Disc-centered fundus crop; 556 x 515 pixels: 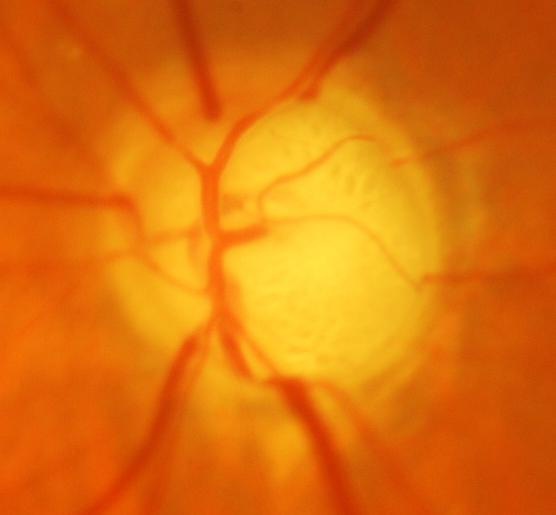

Q: Glaucoma assessment?
A: Evidence of glaucoma.